DR severity per modified Davis staging · nonmydriatic · NIDEK AFC-230 fundus camera · 848 by 848 pixels:
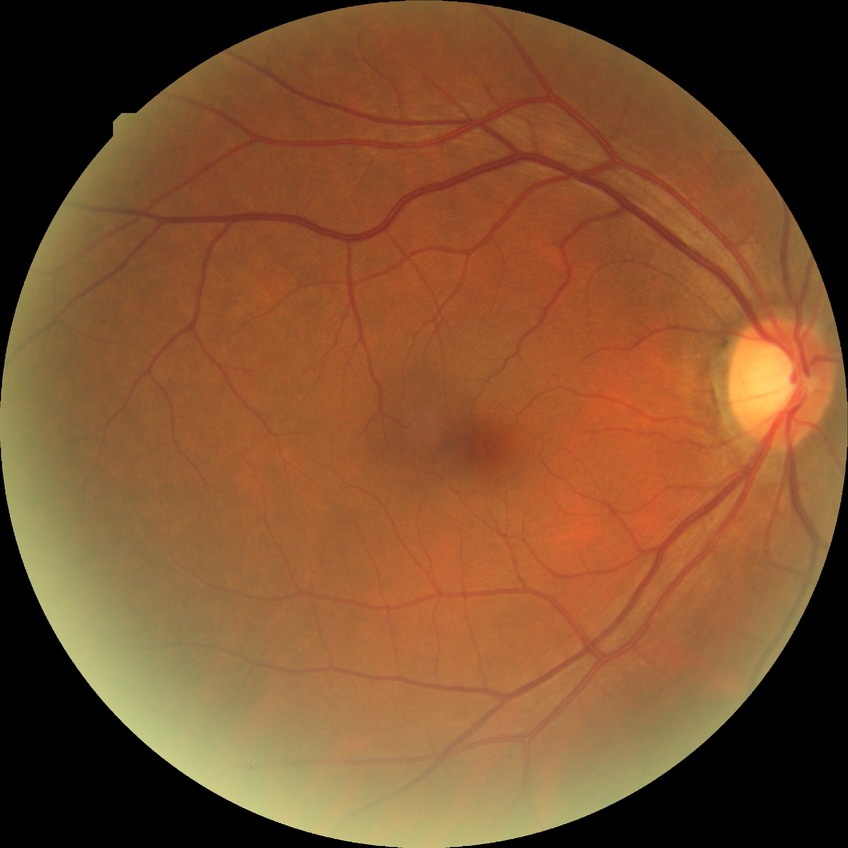
davis_grade: no diabetic retinopathy